1440x1080px; infant wide-field retinal image
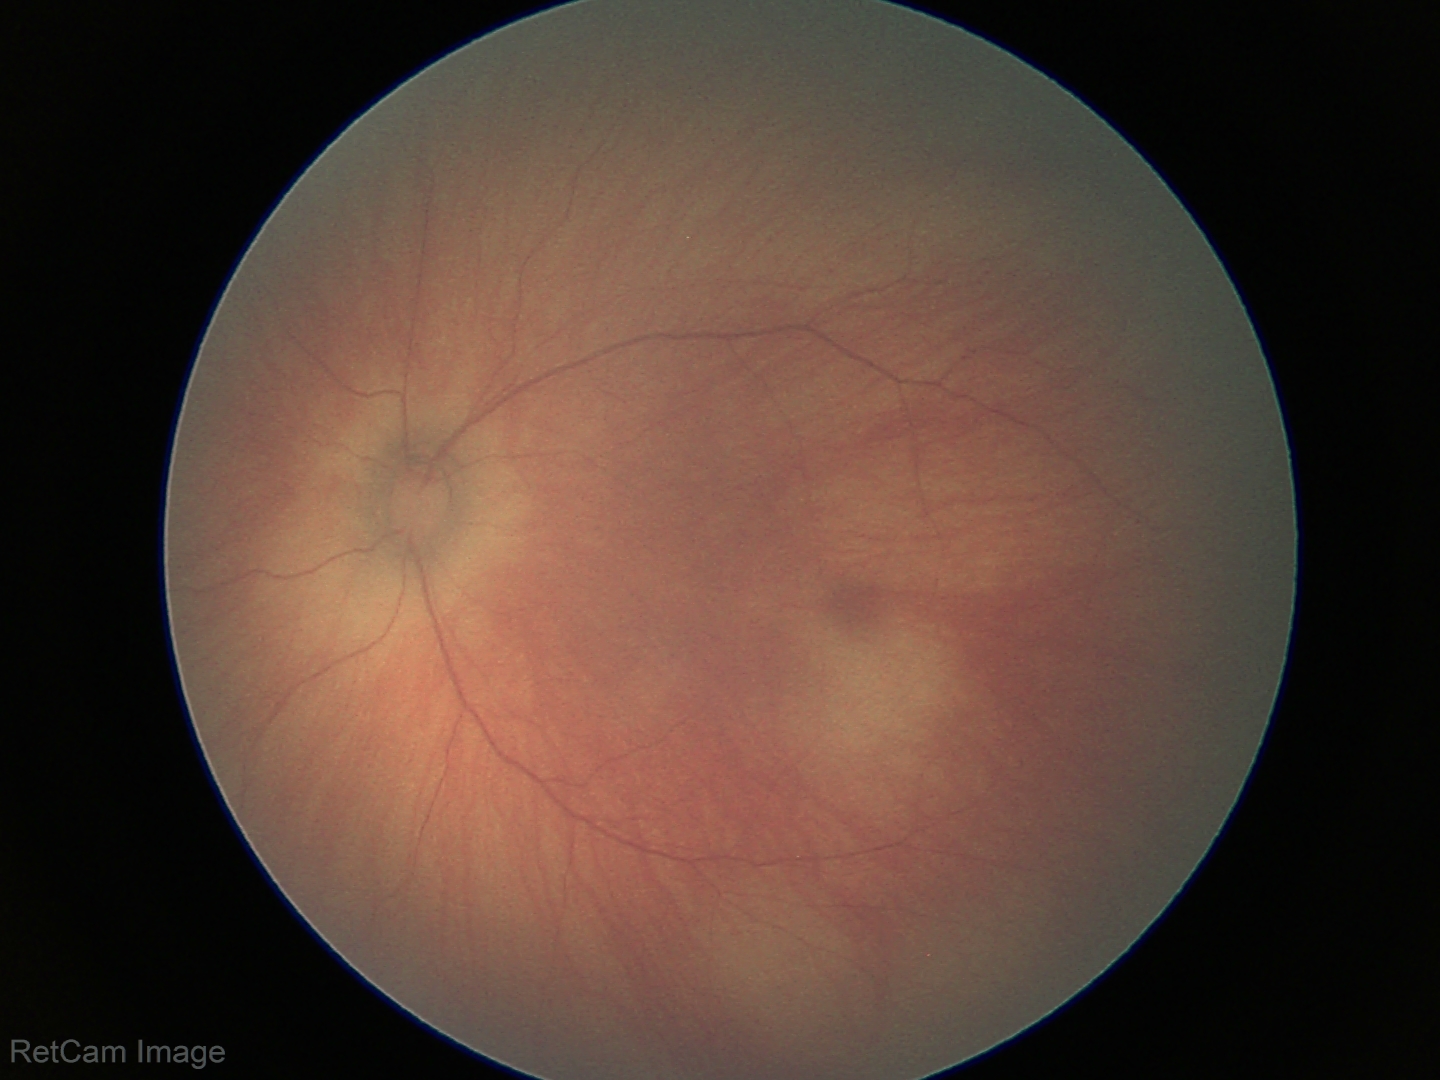

Diagnosis = no abnormalities.